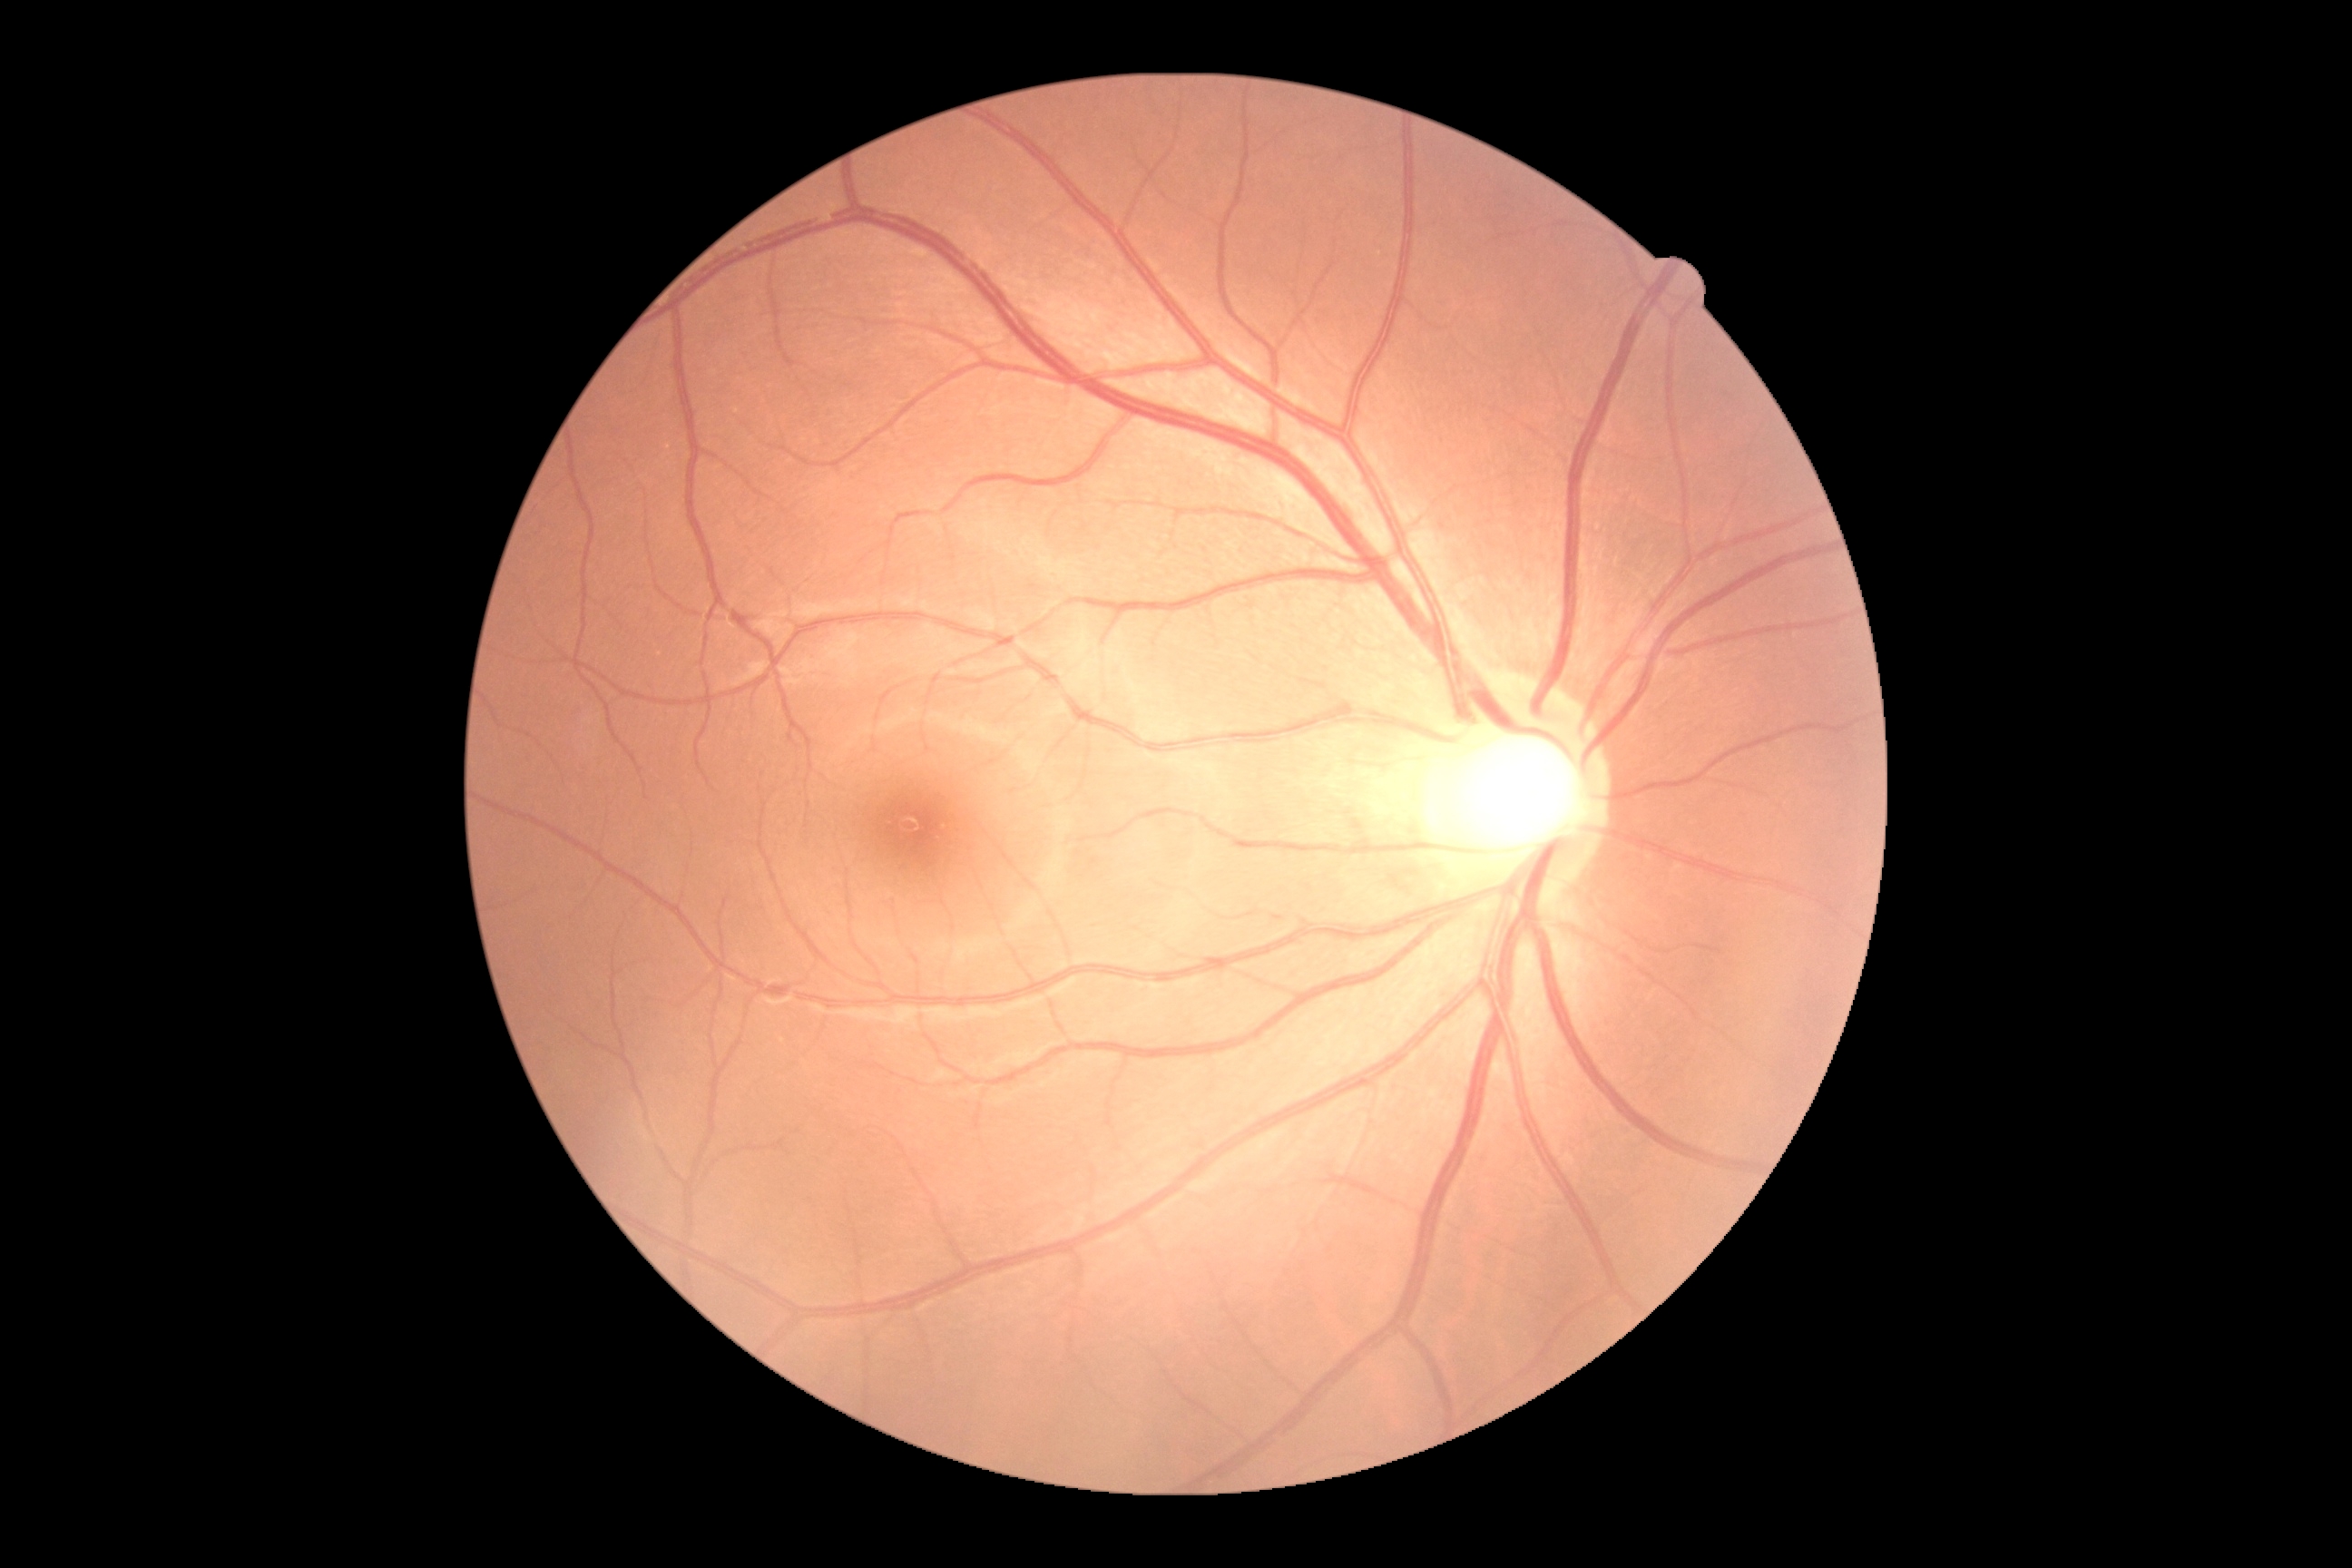

DR: grade 0 (no apparent retinopathy).